Wide-field contact fundus photograph of an infant; 640x480px: 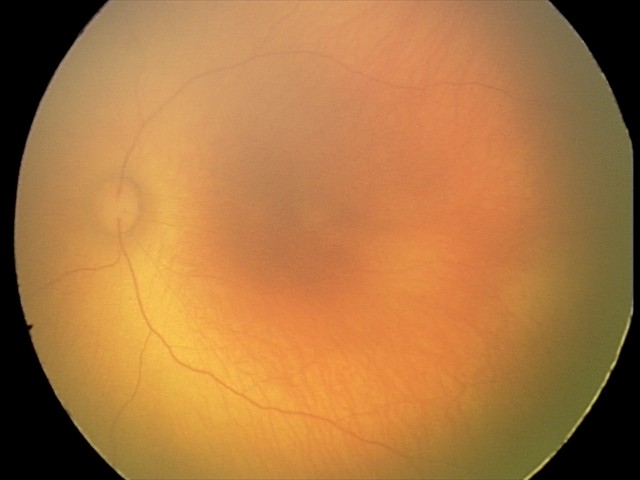

Impression: physiological appearance with no retinal pathology.